848x848. Davis DR grading.
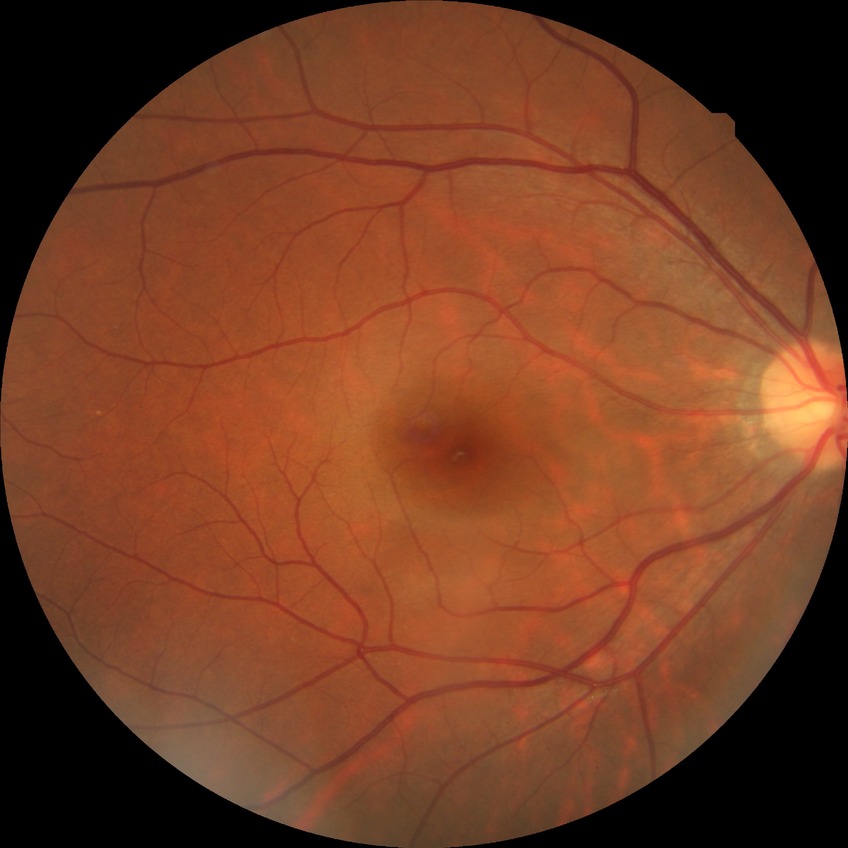 davis_grade: no diabetic retinopathy